2048x1536px; color fundus image:
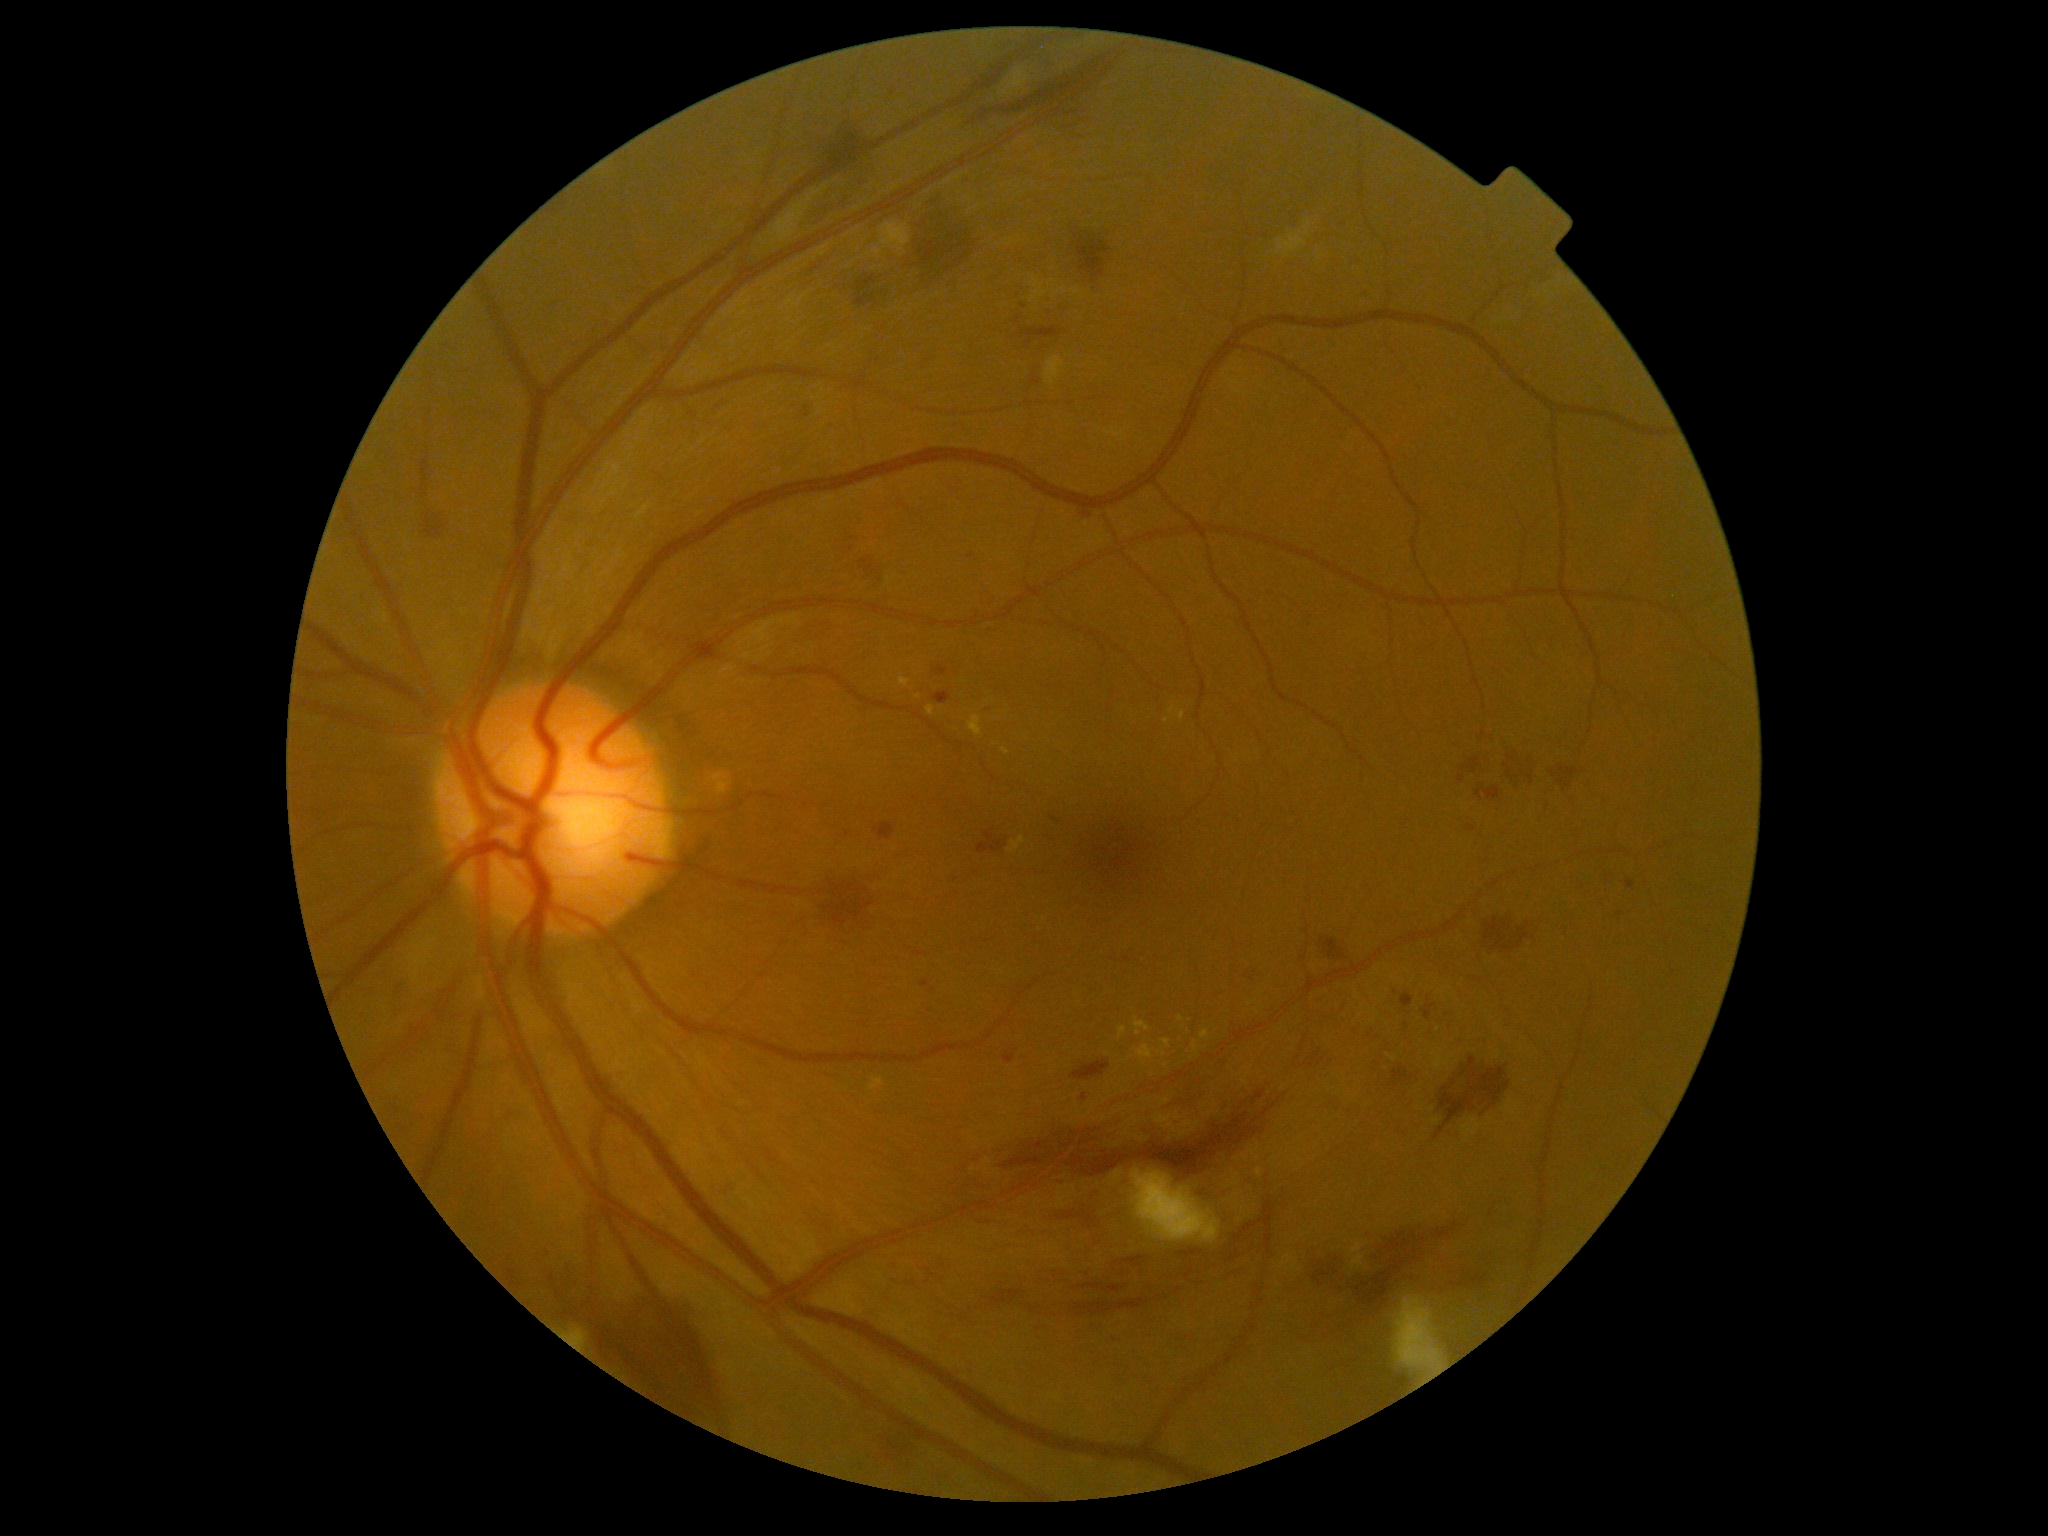

{
  "dr_category": "non-proliferative diabetic retinopathy",
  "dr_grade": "2"
}